2048 x 1536 pixels
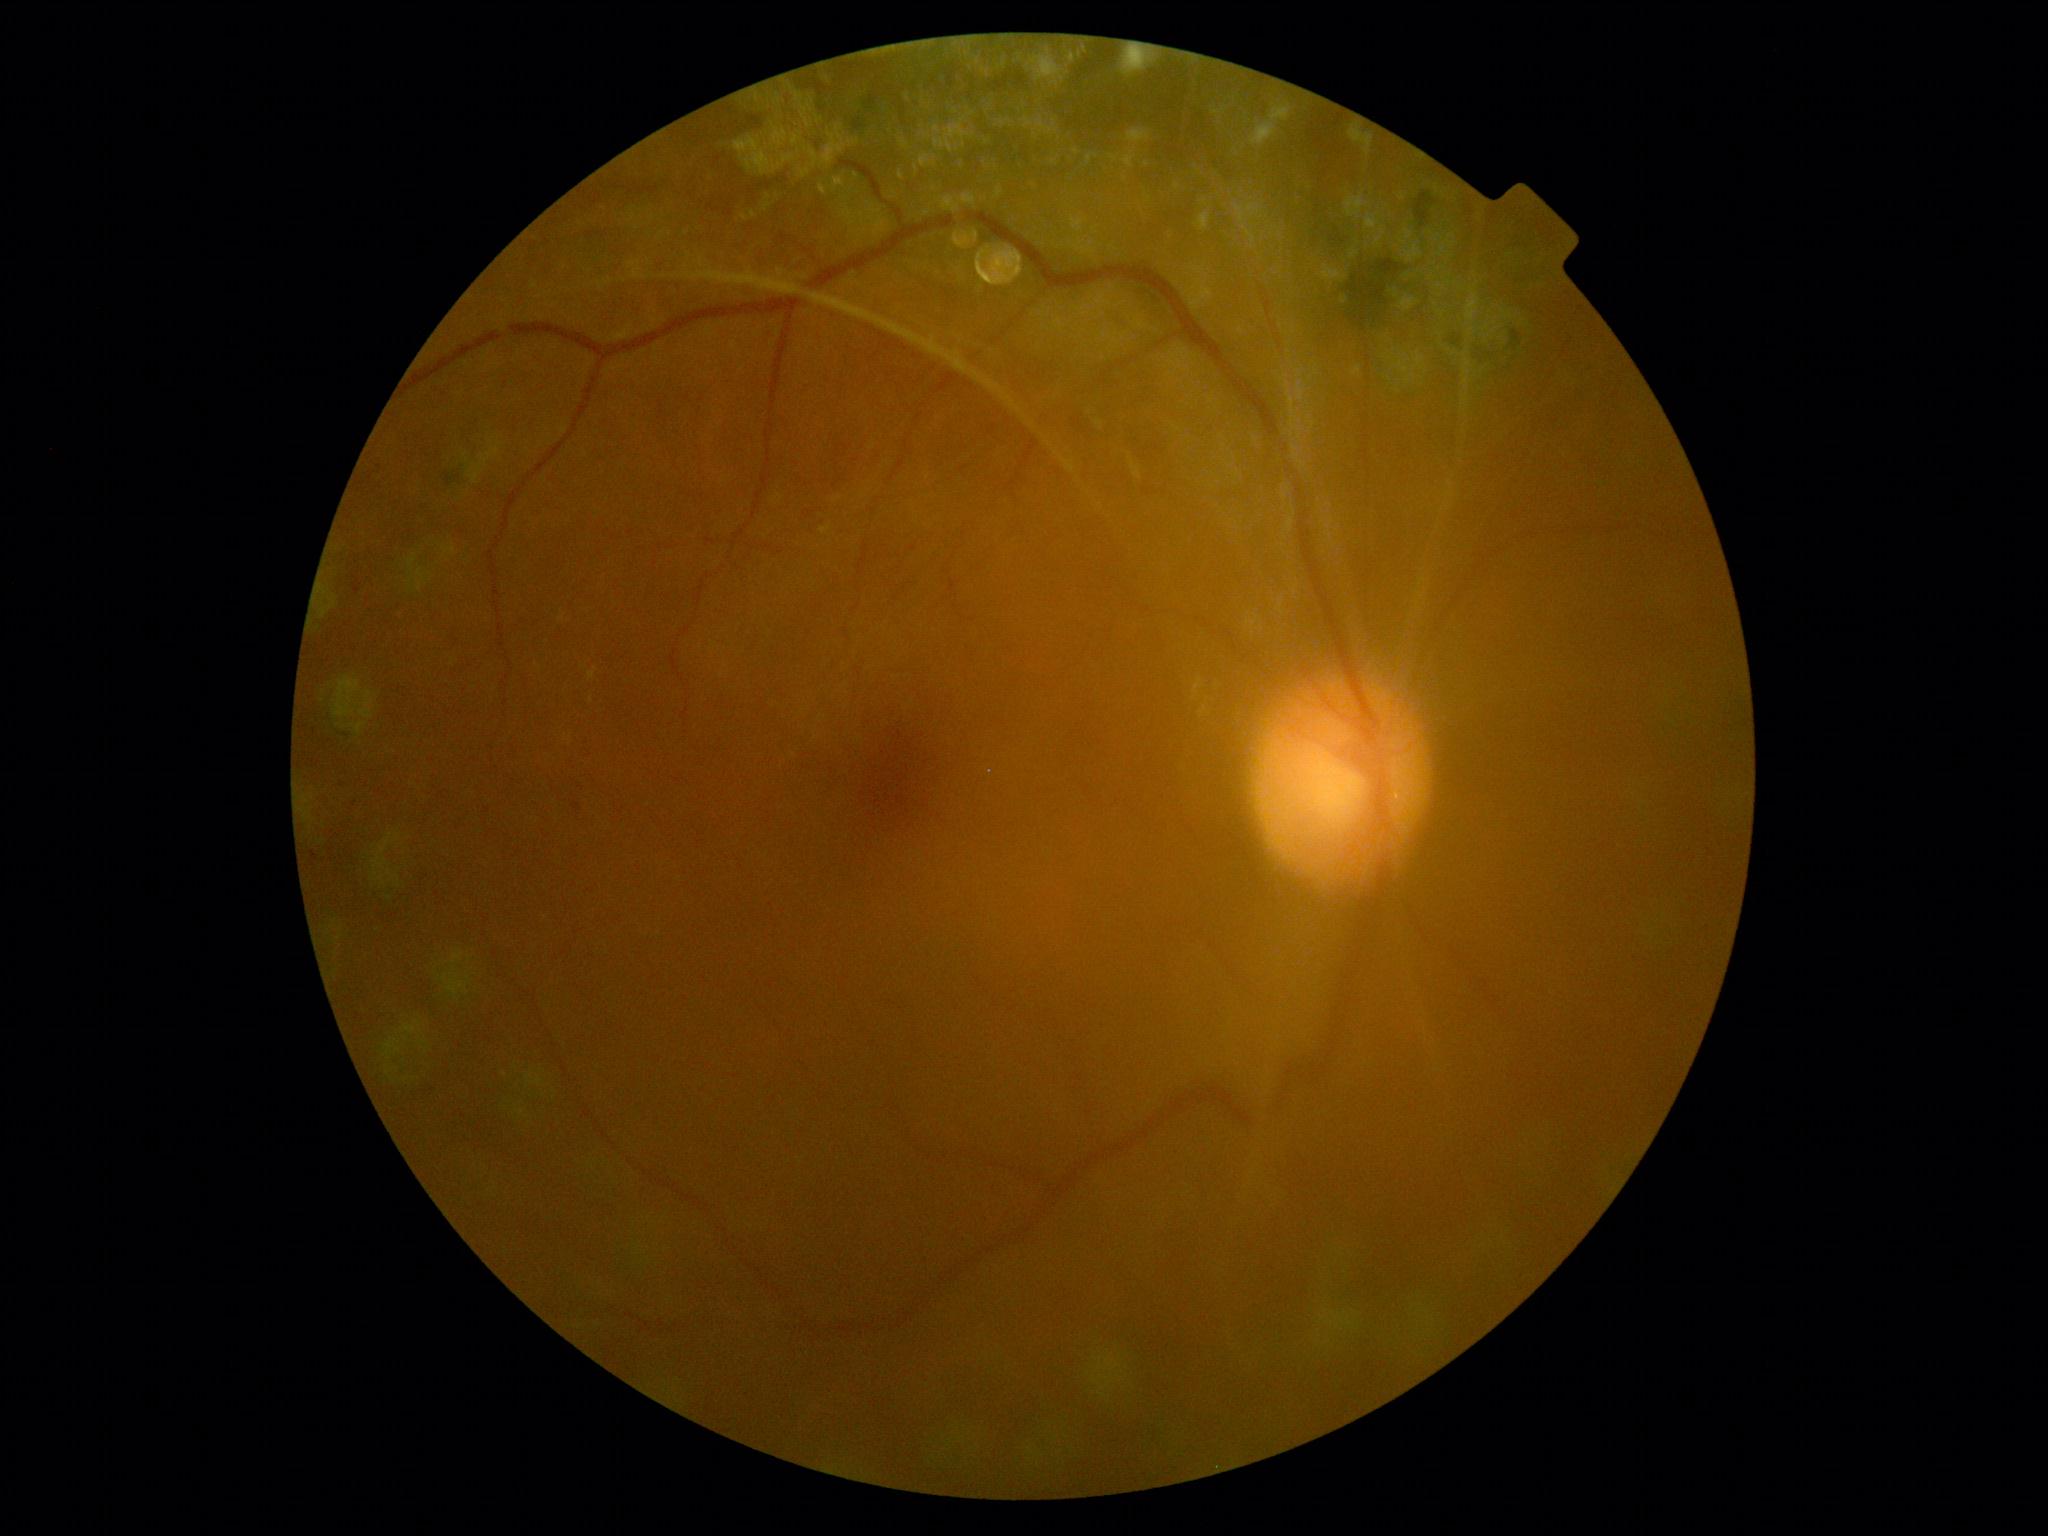 The retinopathy is classified as proliferative diabetic retinopathy.
DR stage is PDR (grade 4).